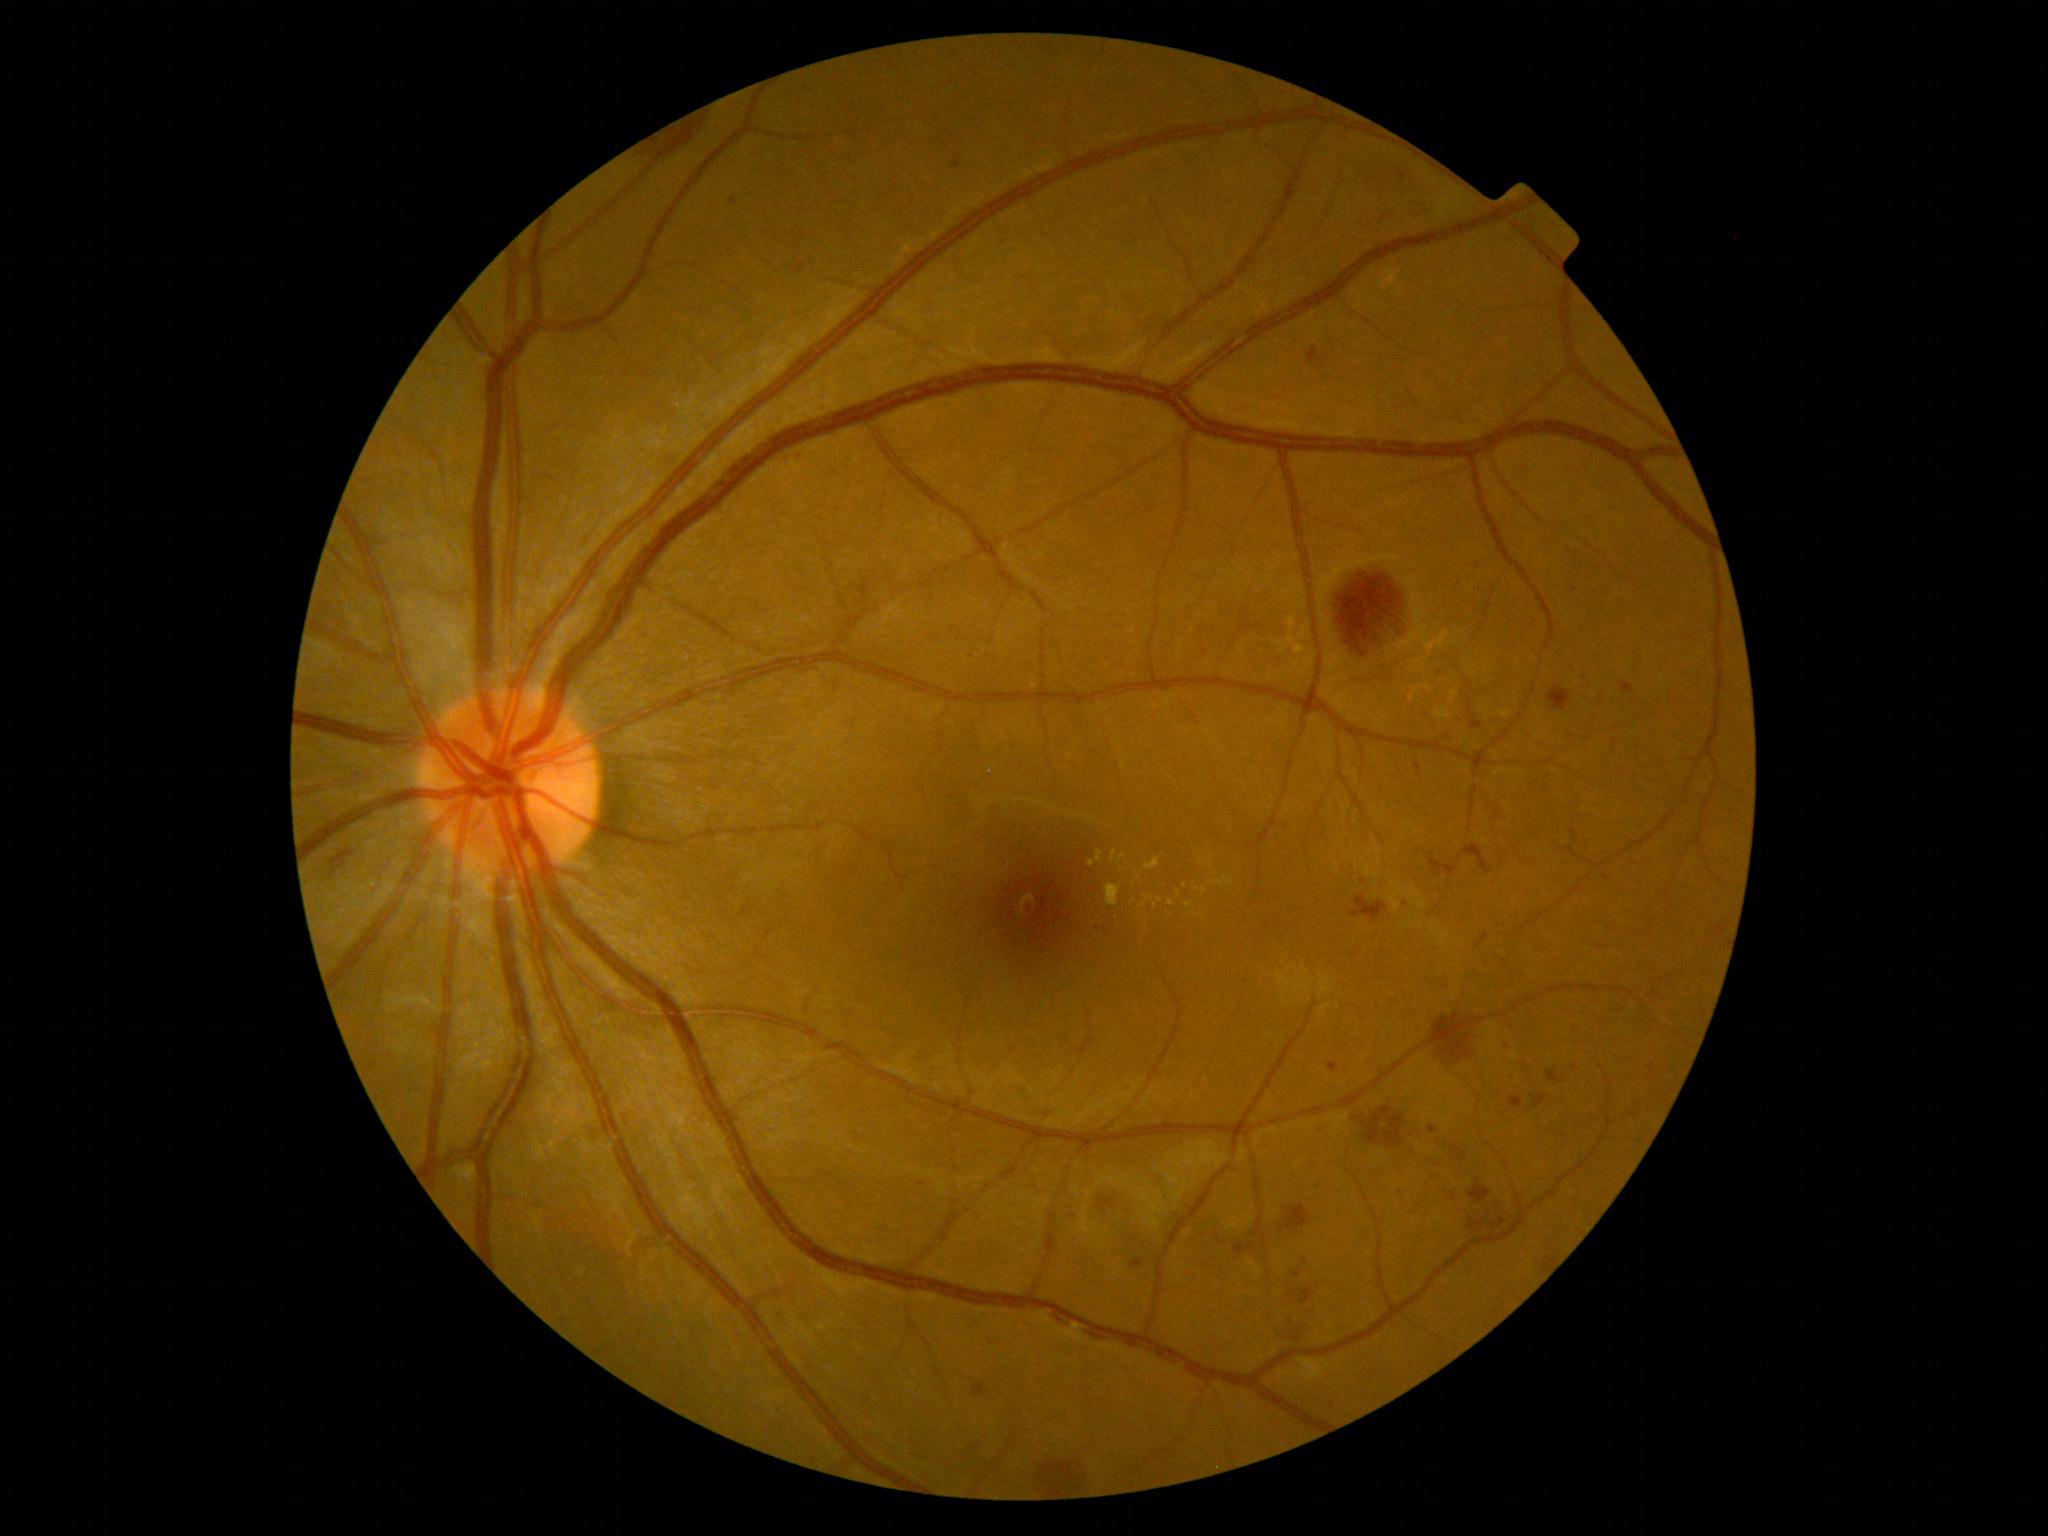
{"partial":true,"dr_grade":2,"lesions":{"he":[[1464,843,1492,875],[1294,1324,1311,1337],[1100,1197,1118,1209],[1430,853,1456,876],[1380,1107,1394,1117],[971,1383,987,1396],[1386,1113,1407,1146],[1331,564,1414,664],[1040,1459,1090,1493],[1446,1148,1470,1161],[1301,1289,1314,1304],[1367,1114,1383,1144],[1493,1220,1506,1227]],"ex":[[1215,876,1234,886],[1096,851,1103,862],[1105,883,1122,906],[1110,850,1118,863]],"ex_small":[[1189,905],[1178,893],[1133,903],[1143,905],[1155,906],[1210,882],[1210,864]],"ma":[[1622,683,1633,696],[1328,1062,1340,1073],[1292,1271,1301,1277],[1429,1125,1437,1134],[1401,898,1407,906],[1510,1095,1523,1108],[1131,1259,1145,1269],[951,156,960,169],[1308,348,1322,364]],"ma_small":[[1507,1046],[734,201],[1305,1262],[1574,590],[1574,1067],[1098,928],[921,1183]],"se":null}}